Color fundus image:
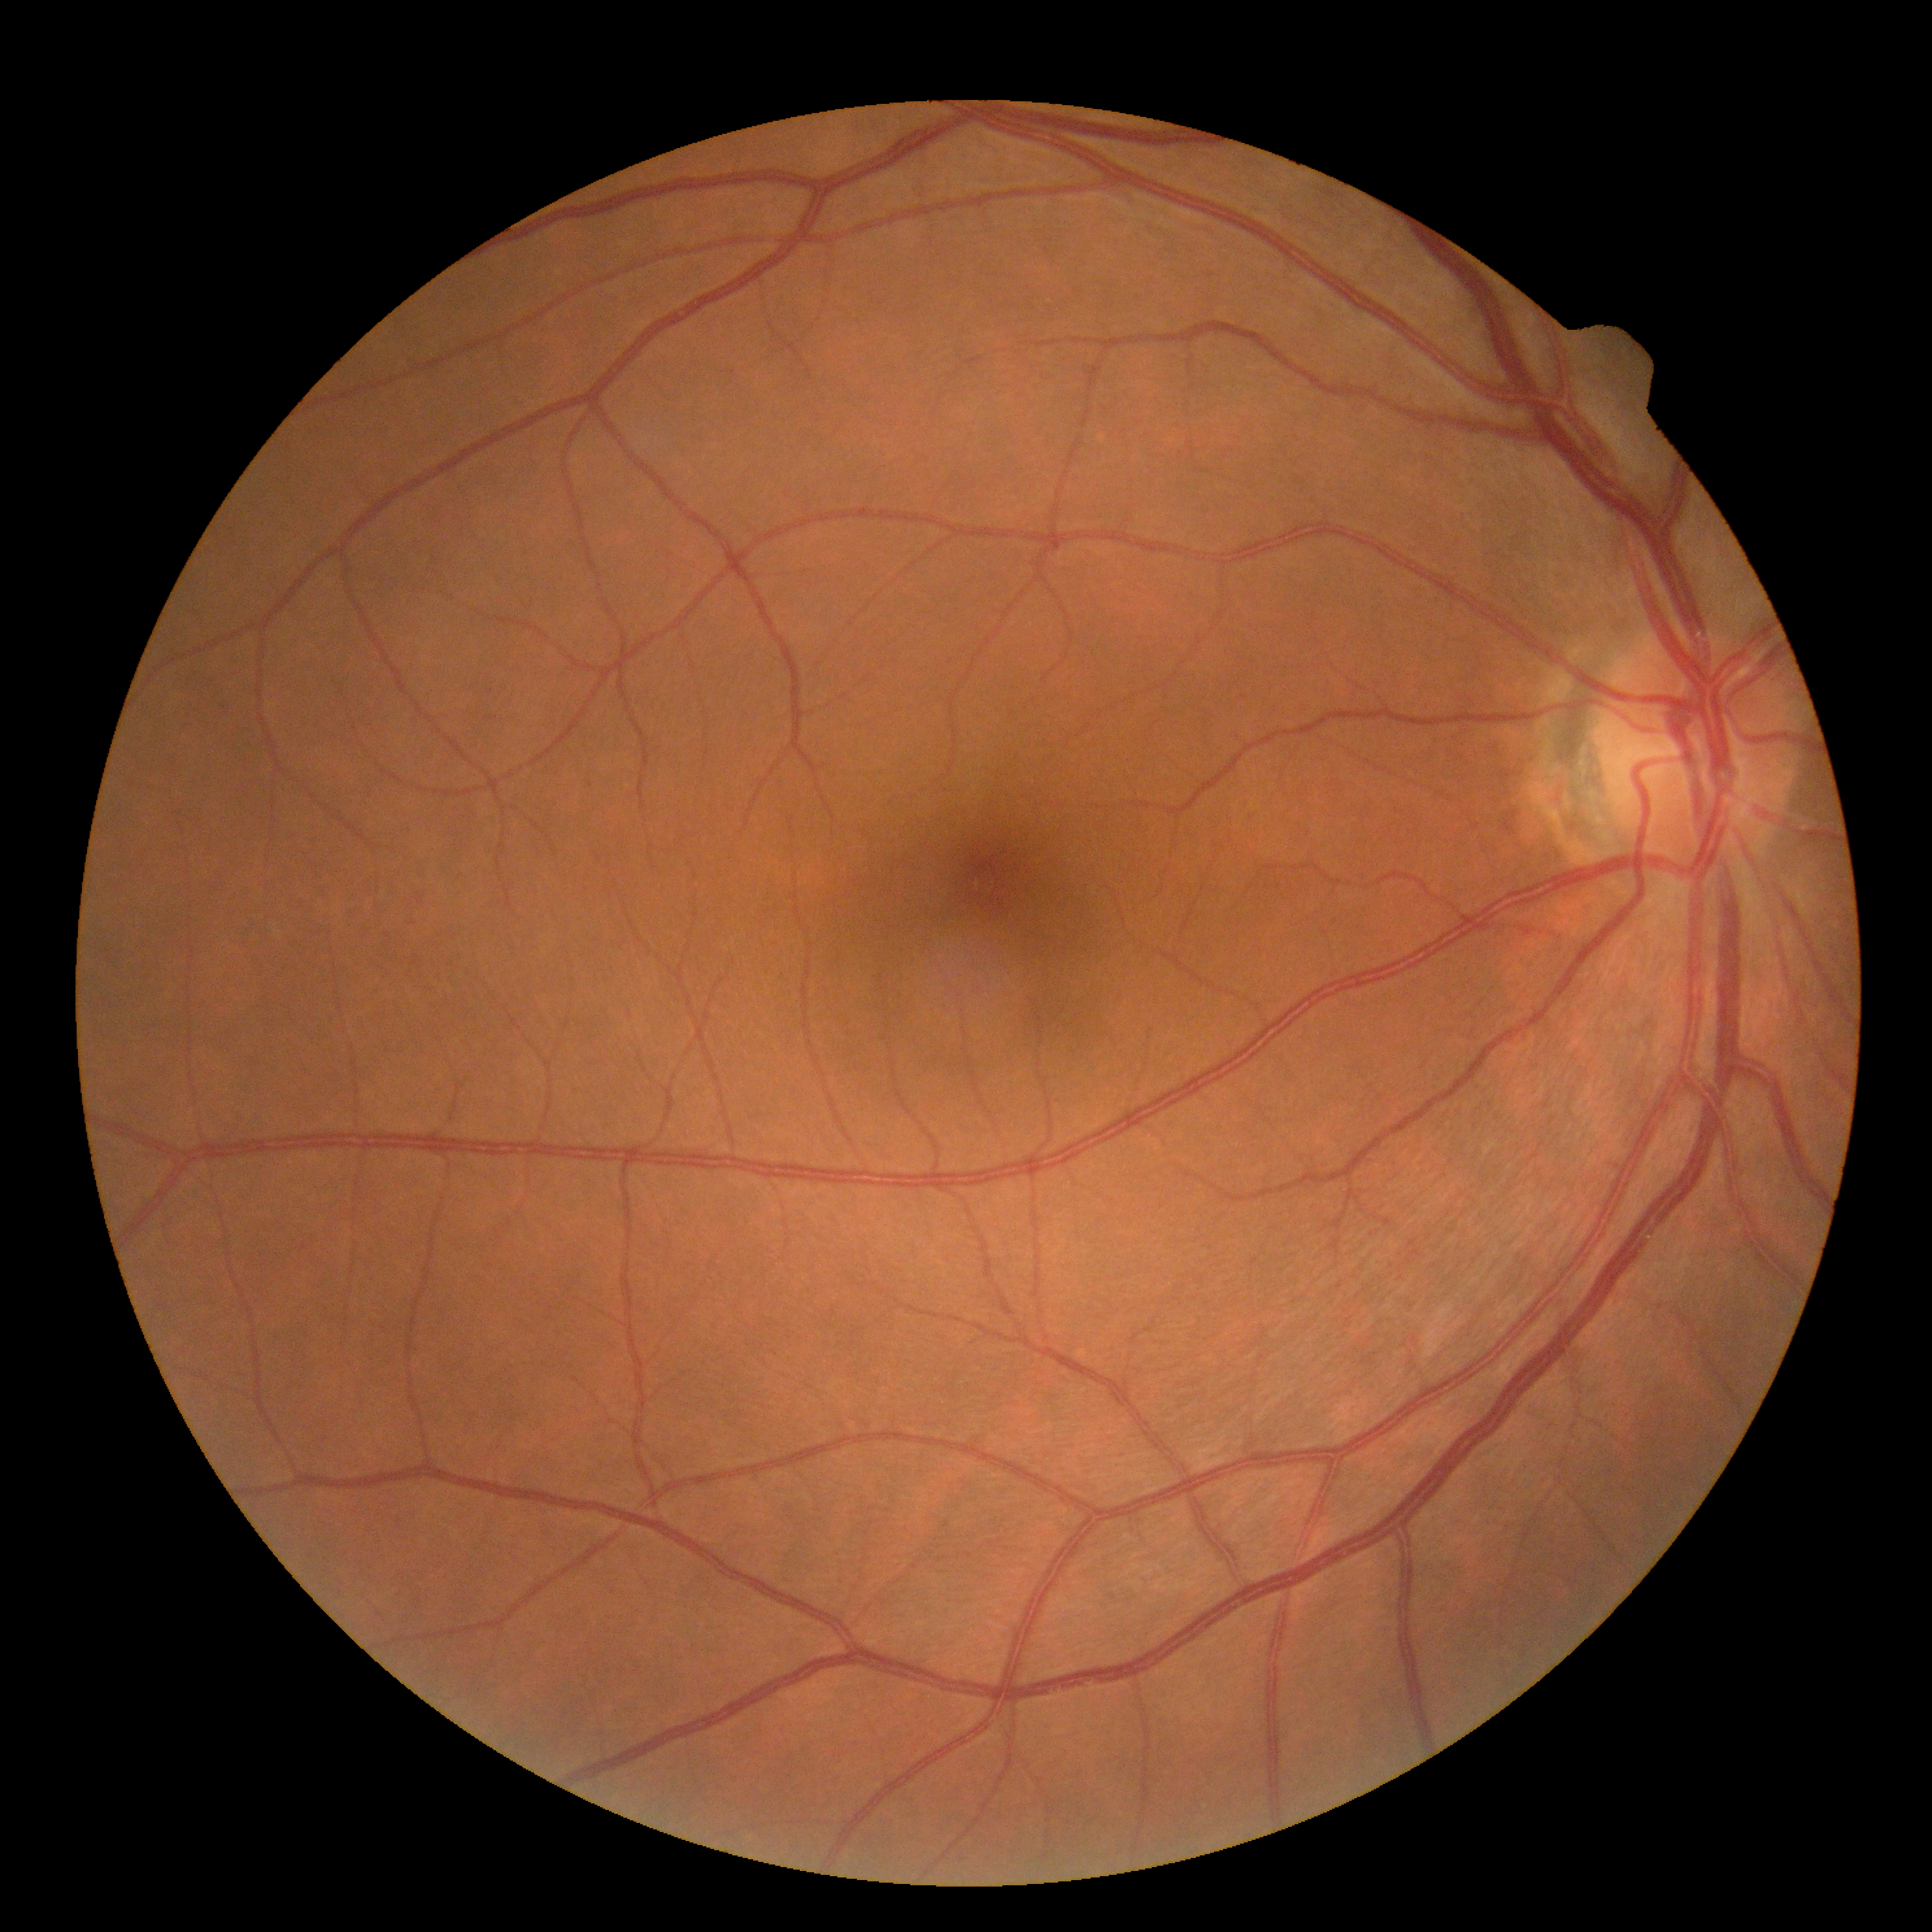

Diabetic retinopathy: grade 0 (no apparent retinopathy).
No apparent diabetic retinopathy.